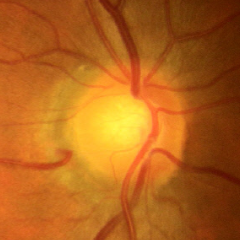
Q: Glaucoma assessment?
A: No signs of glaucoma.